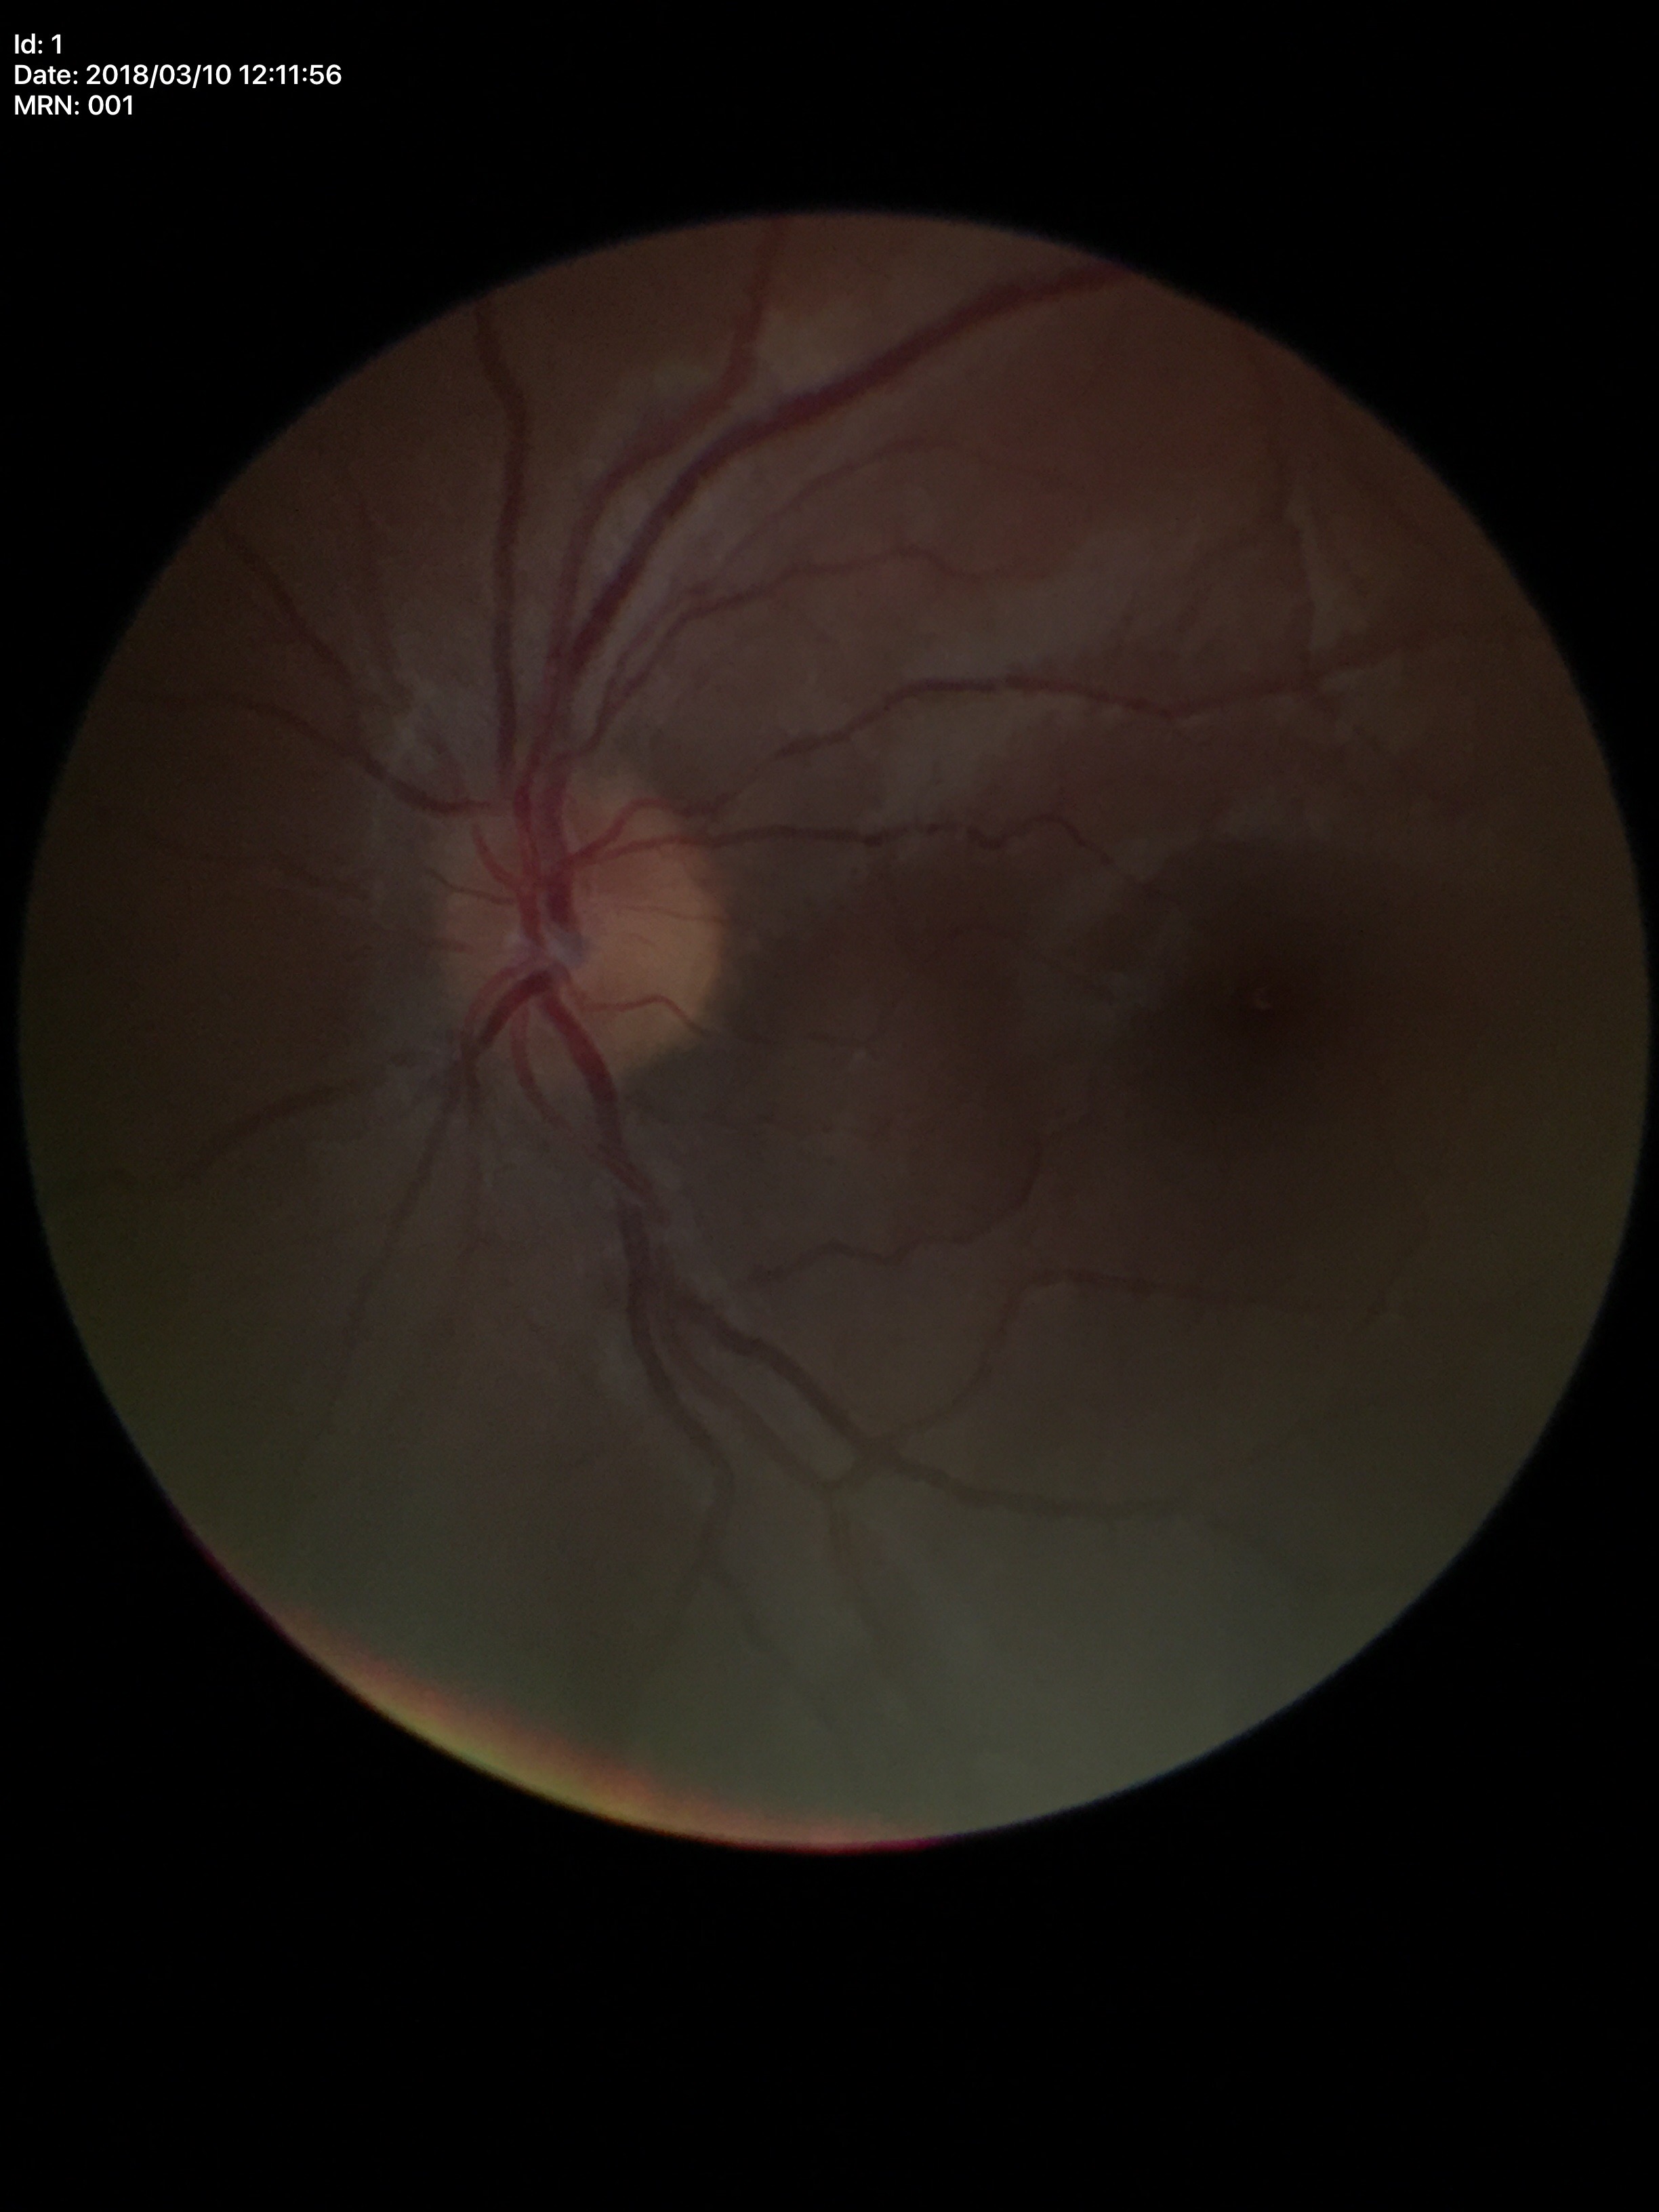 Annotations:
* Glaucoma evaluation · no suspicious findings (5/5 ophthalmologists in agreement)
* vertical cup-disc ratio · 0.40
* area cup-to-disc ratio · 0.19